45° field of view
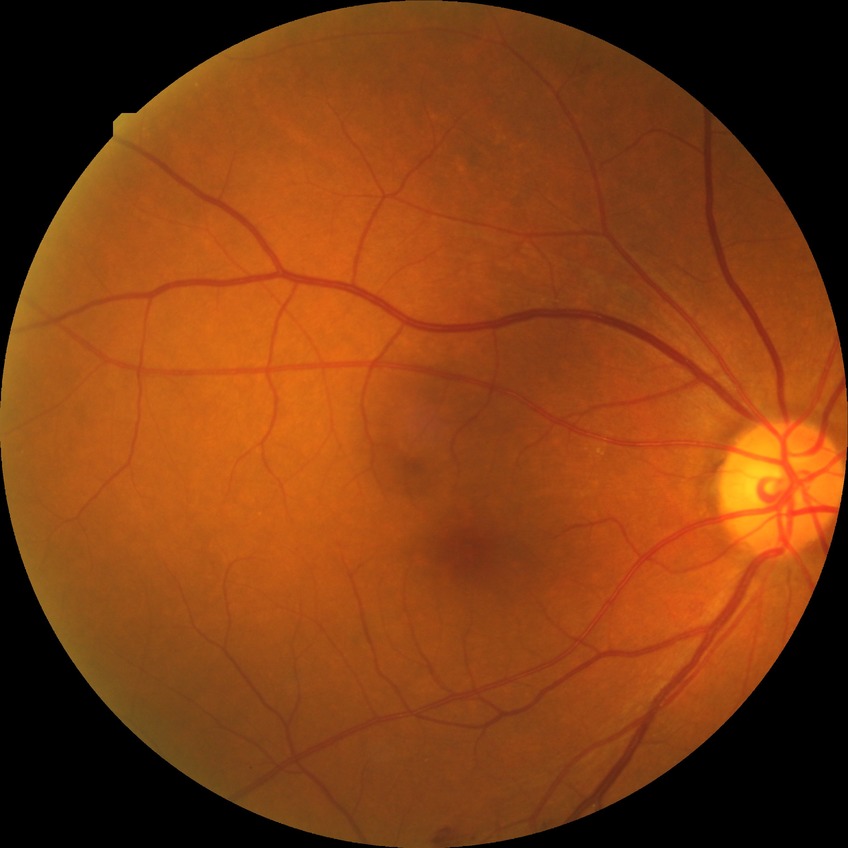 Disease class: non-proliferative diabetic retinopathy.
Diabetic retinopathy (DR) is SDR (simple diabetic retinopathy).